Fundus photo · non-mydriatic fundus camera · 240 by 240 pixels.
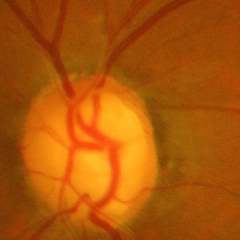 Glaucoma stage = severe glaucomatous damage.